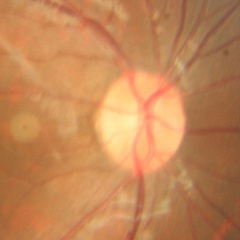
Glaucoma status: no glaucomatous changes.